Wide-field fundus photograph of an infant · 640x480px · captured with the Clarity RetCam 3 (130° field of view): 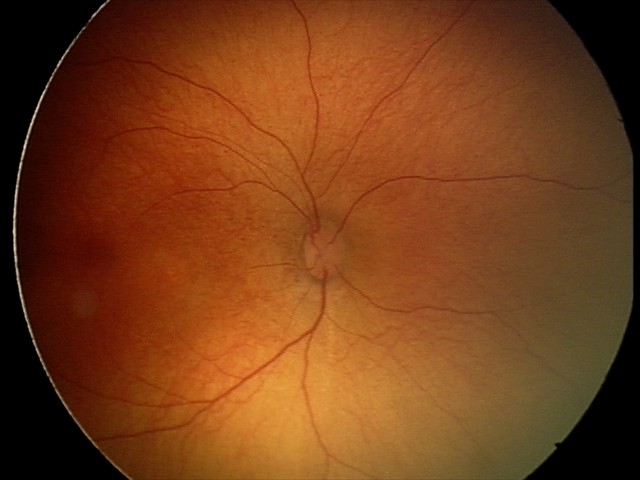

Q: What is the screening diagnosis?
A: physiological retinal finding